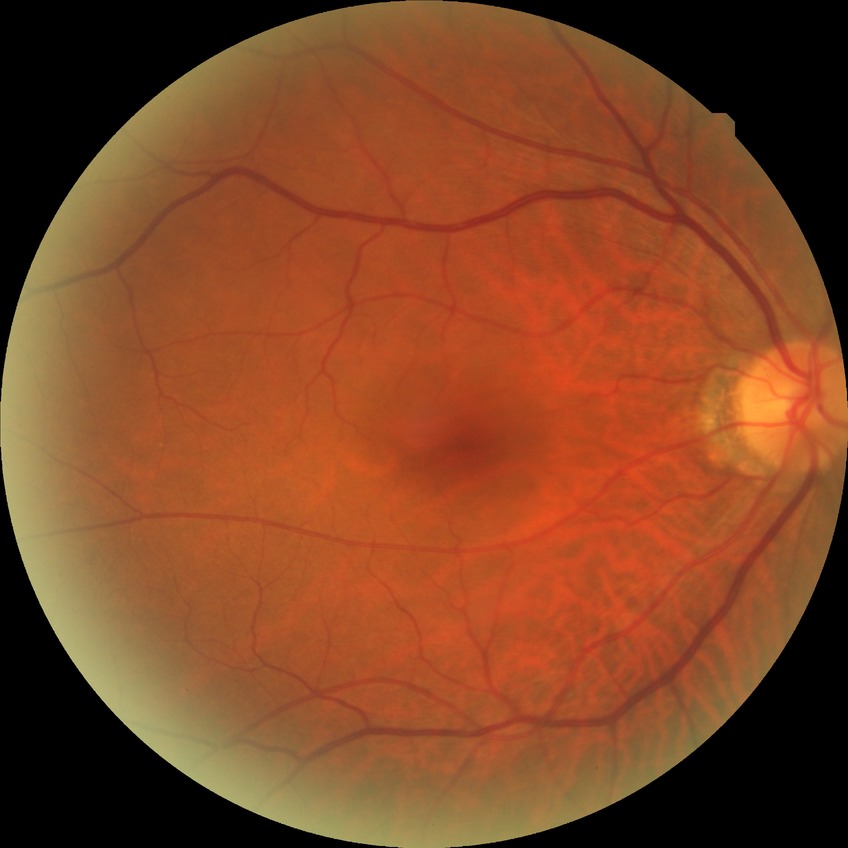
No signs of diabetic retinopathy. Modified Davis grade is NDR.